Color fundus image. NIDEK AFC-230. Image size 848x848. Nonmydriatic.
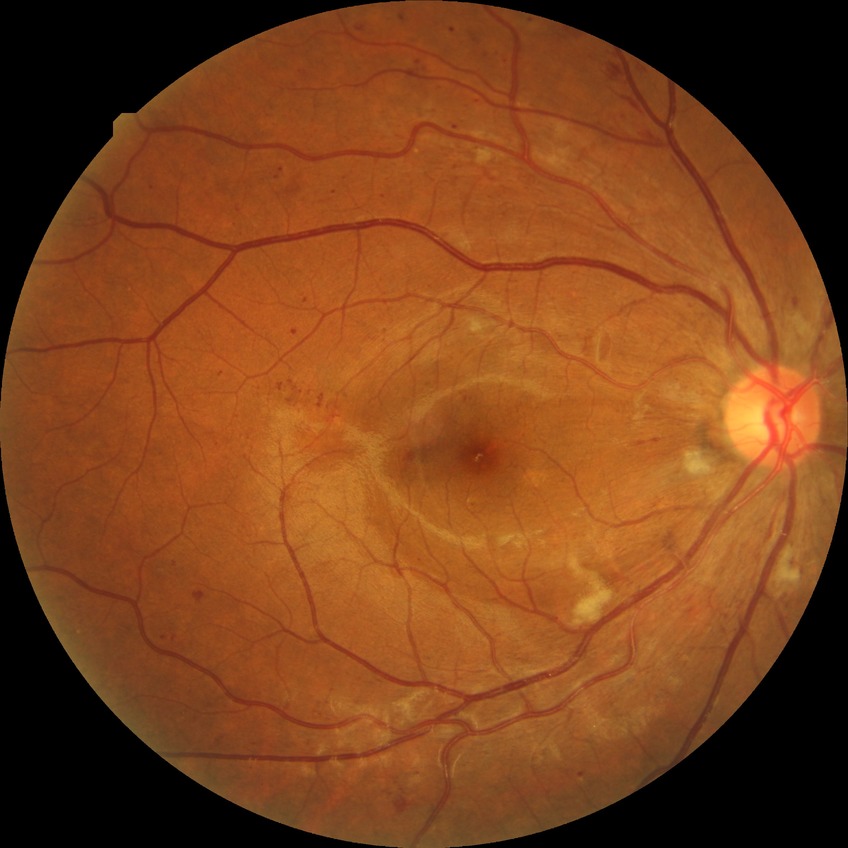

Findings:
– DR grade — PPDR
– DR class — non-proliferative diabetic retinopathy